CFP; Remidio Fundus on Phone; 1659x2212px — 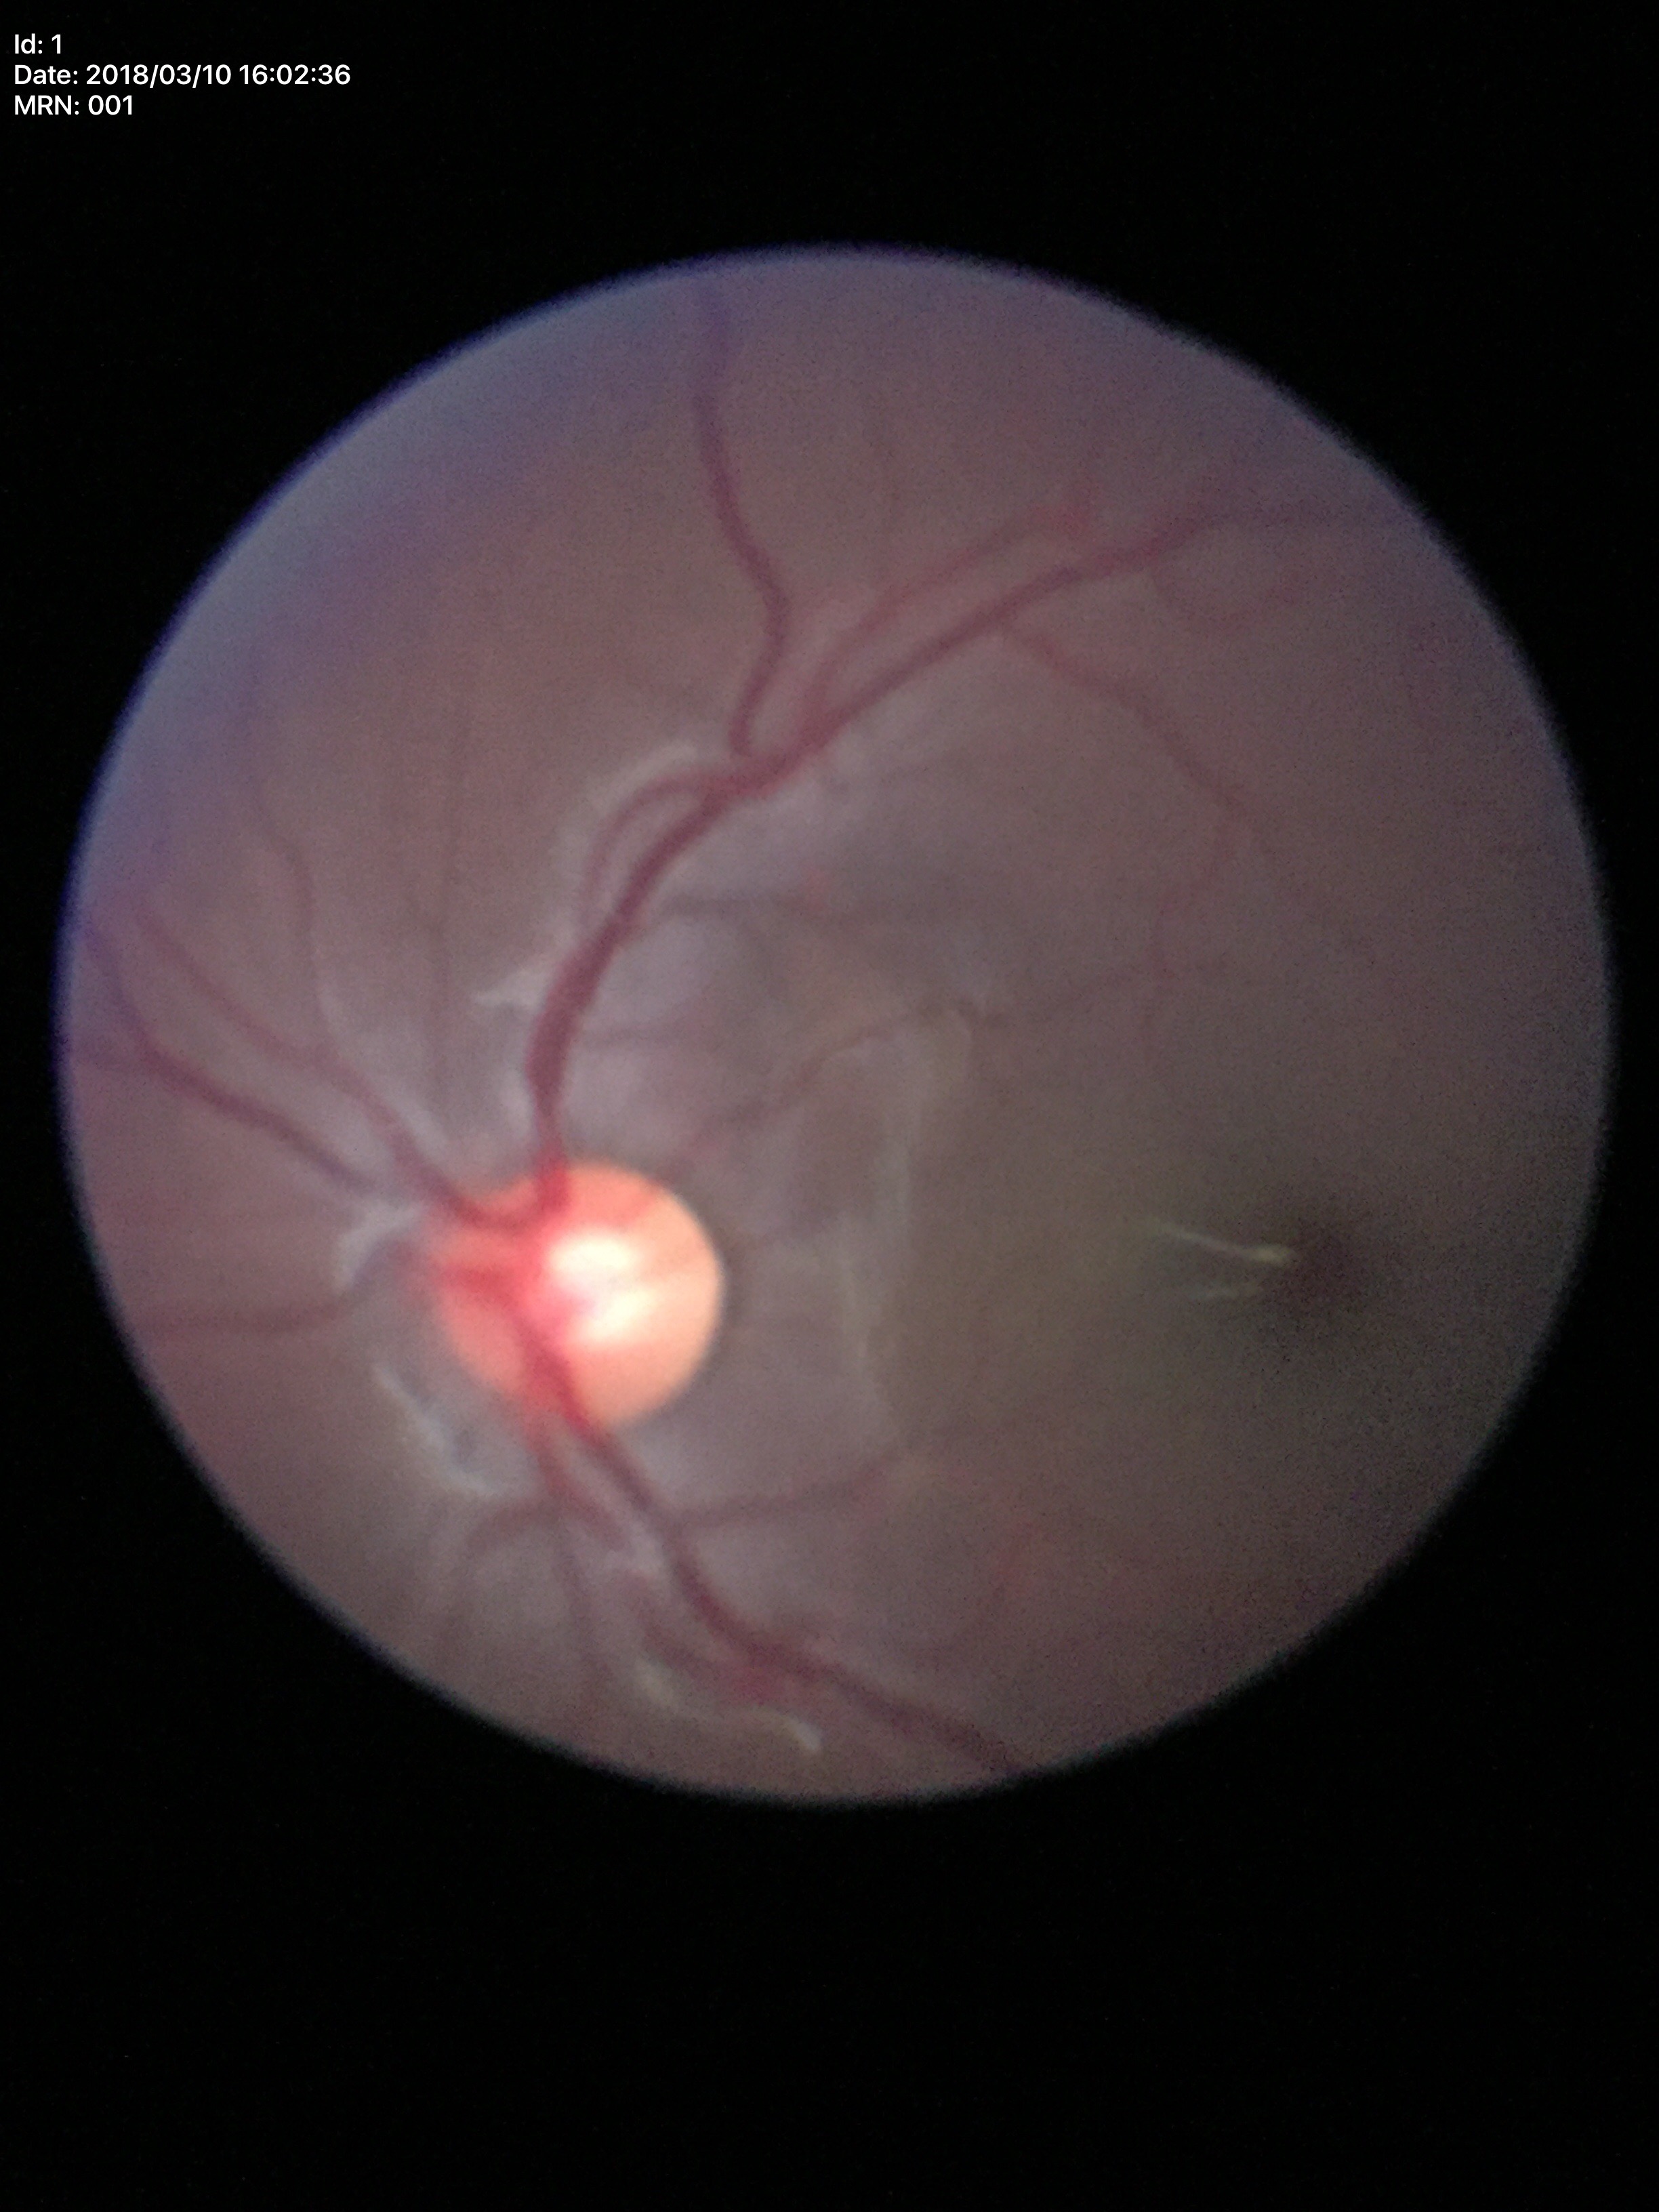 Glaucoma screening impression: no suspicious findings.
VCDR of 0.54.